Graded on the modified Davis scale.
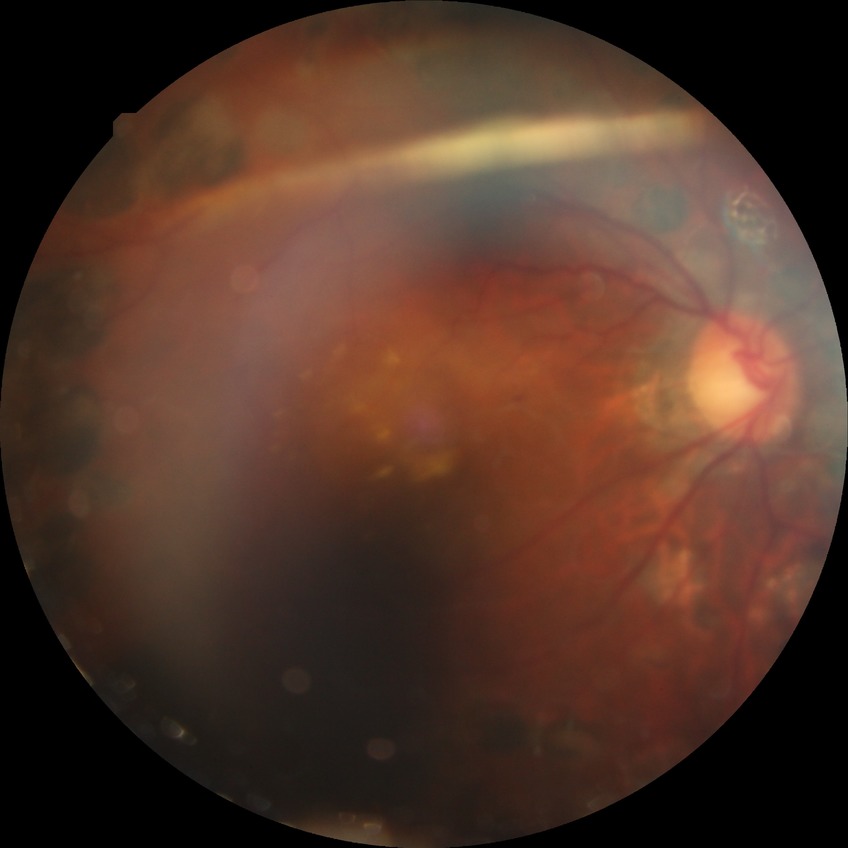
Diabetic retinopathy (DR): PDR (proliferative diabetic retinopathy).